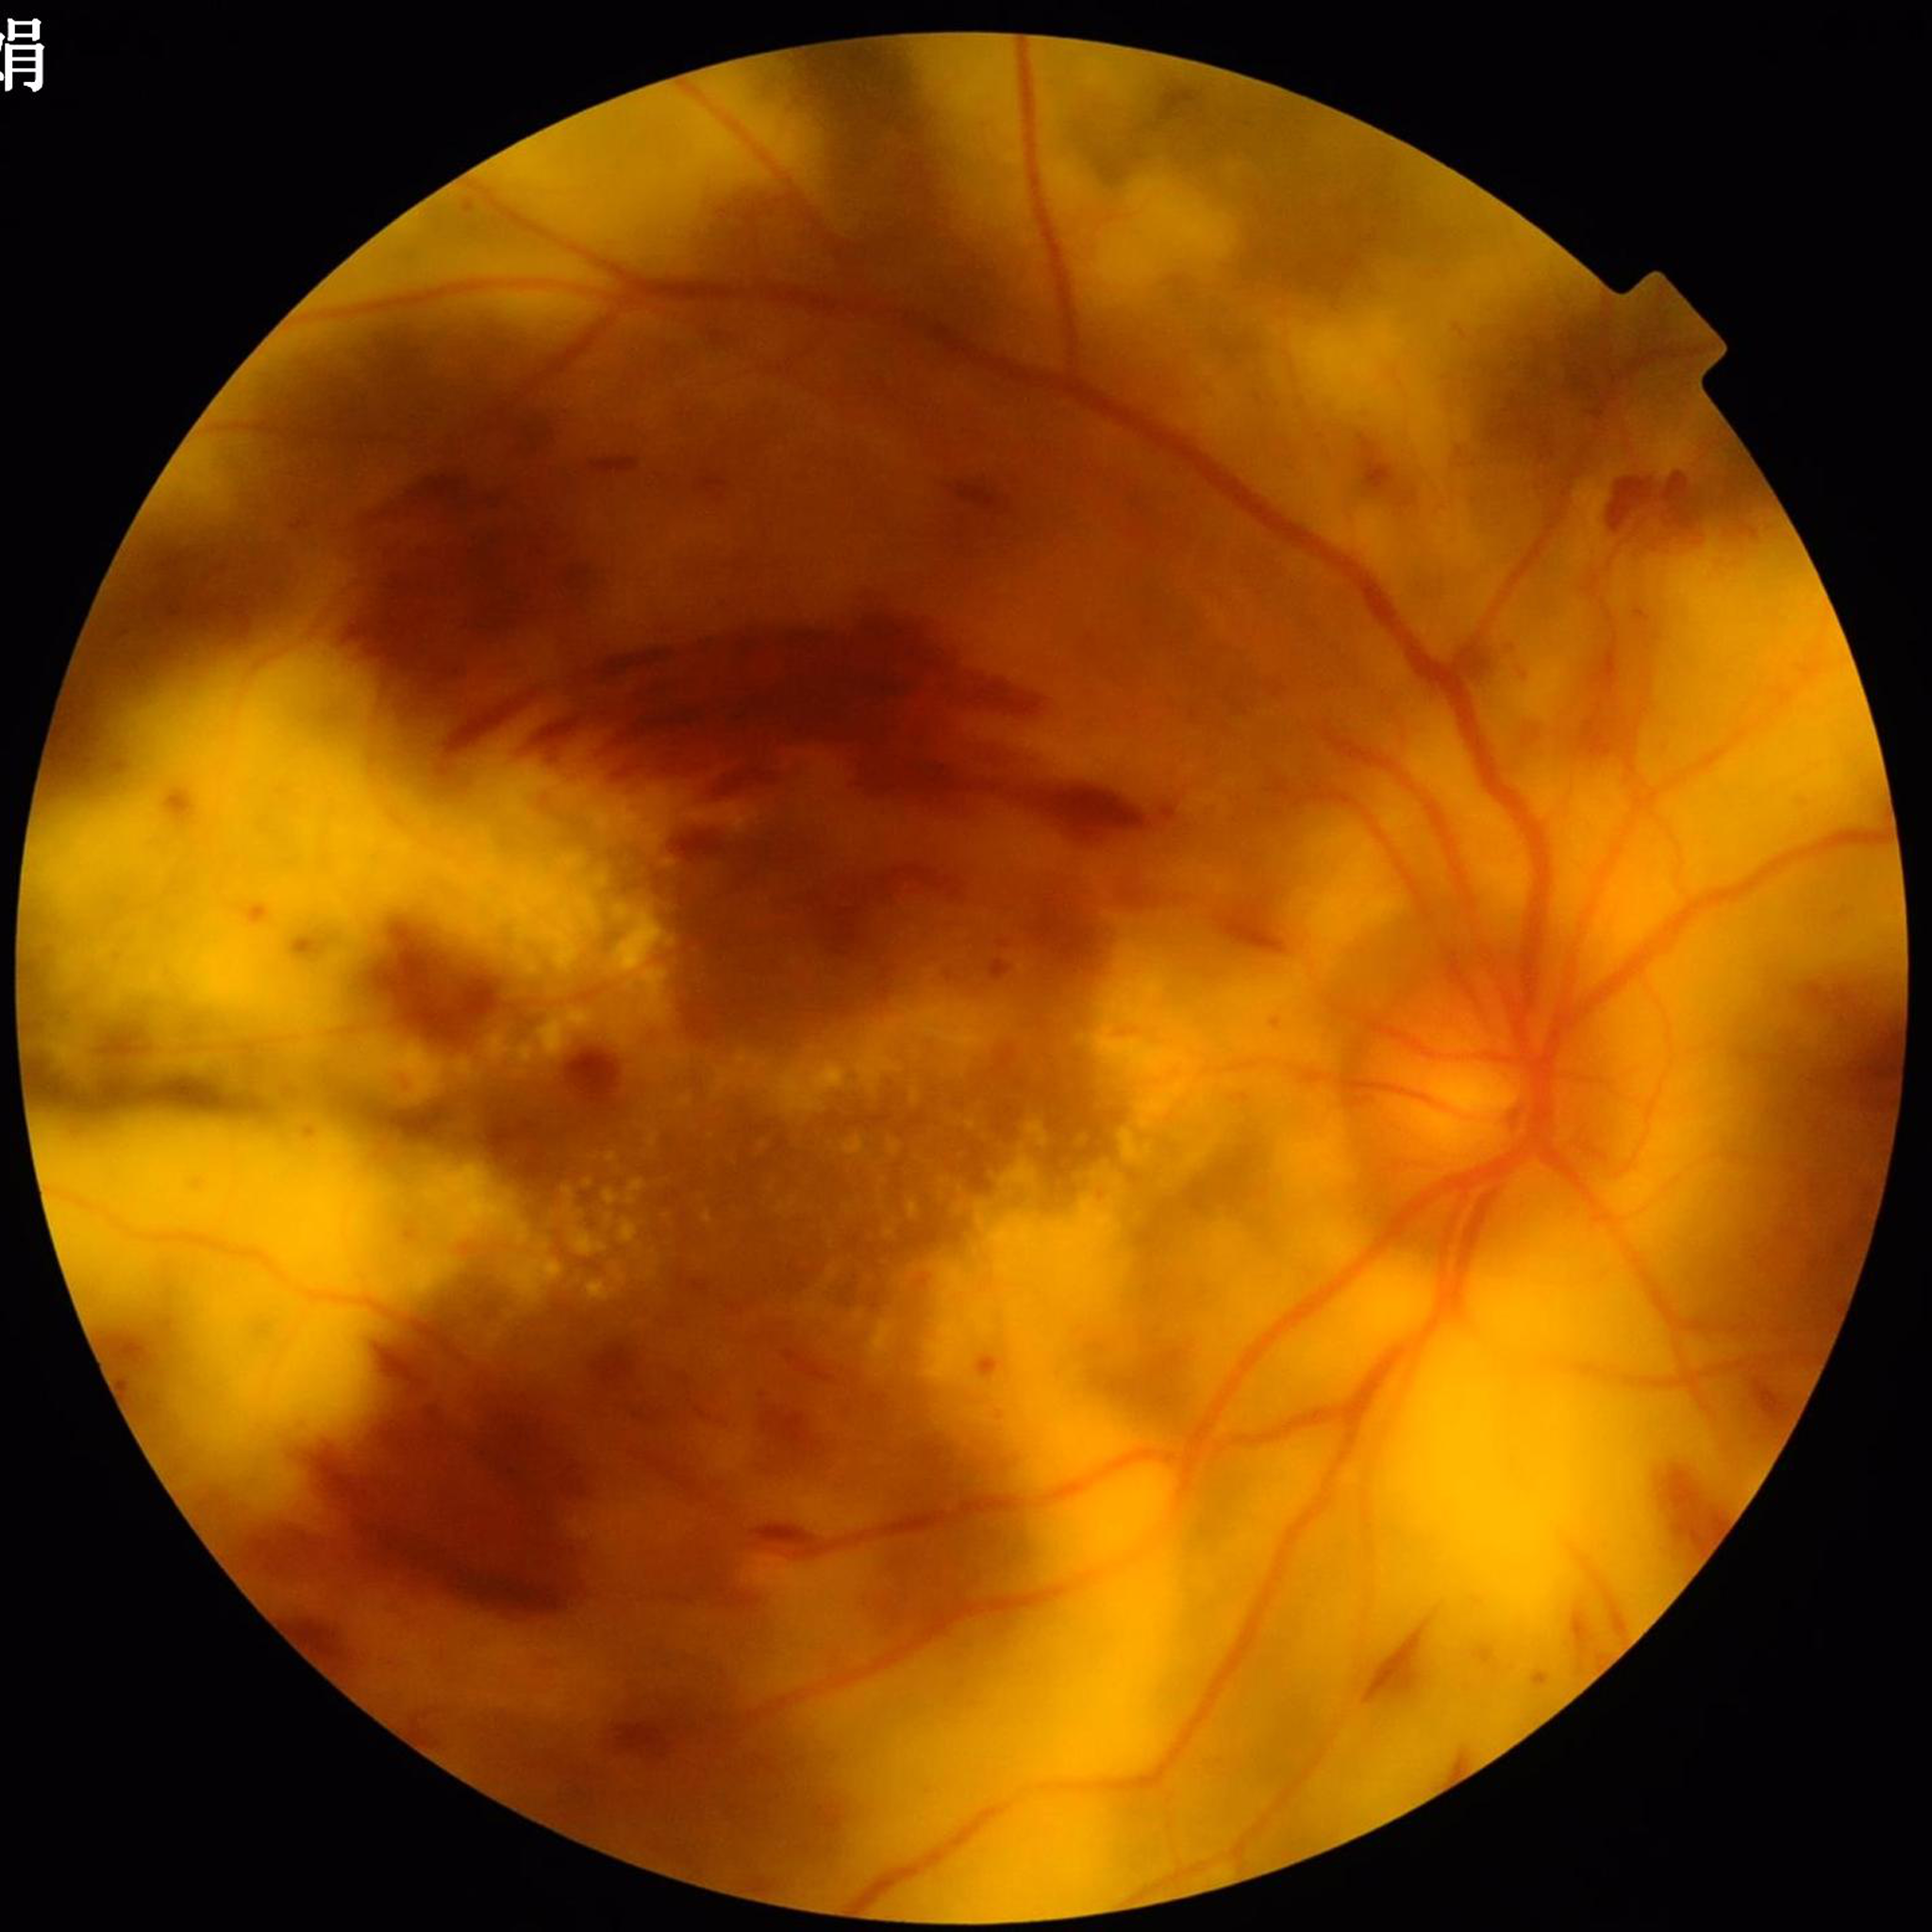
  image_quality: suboptimal — blur
  diagnosis: diabetic retinopathy